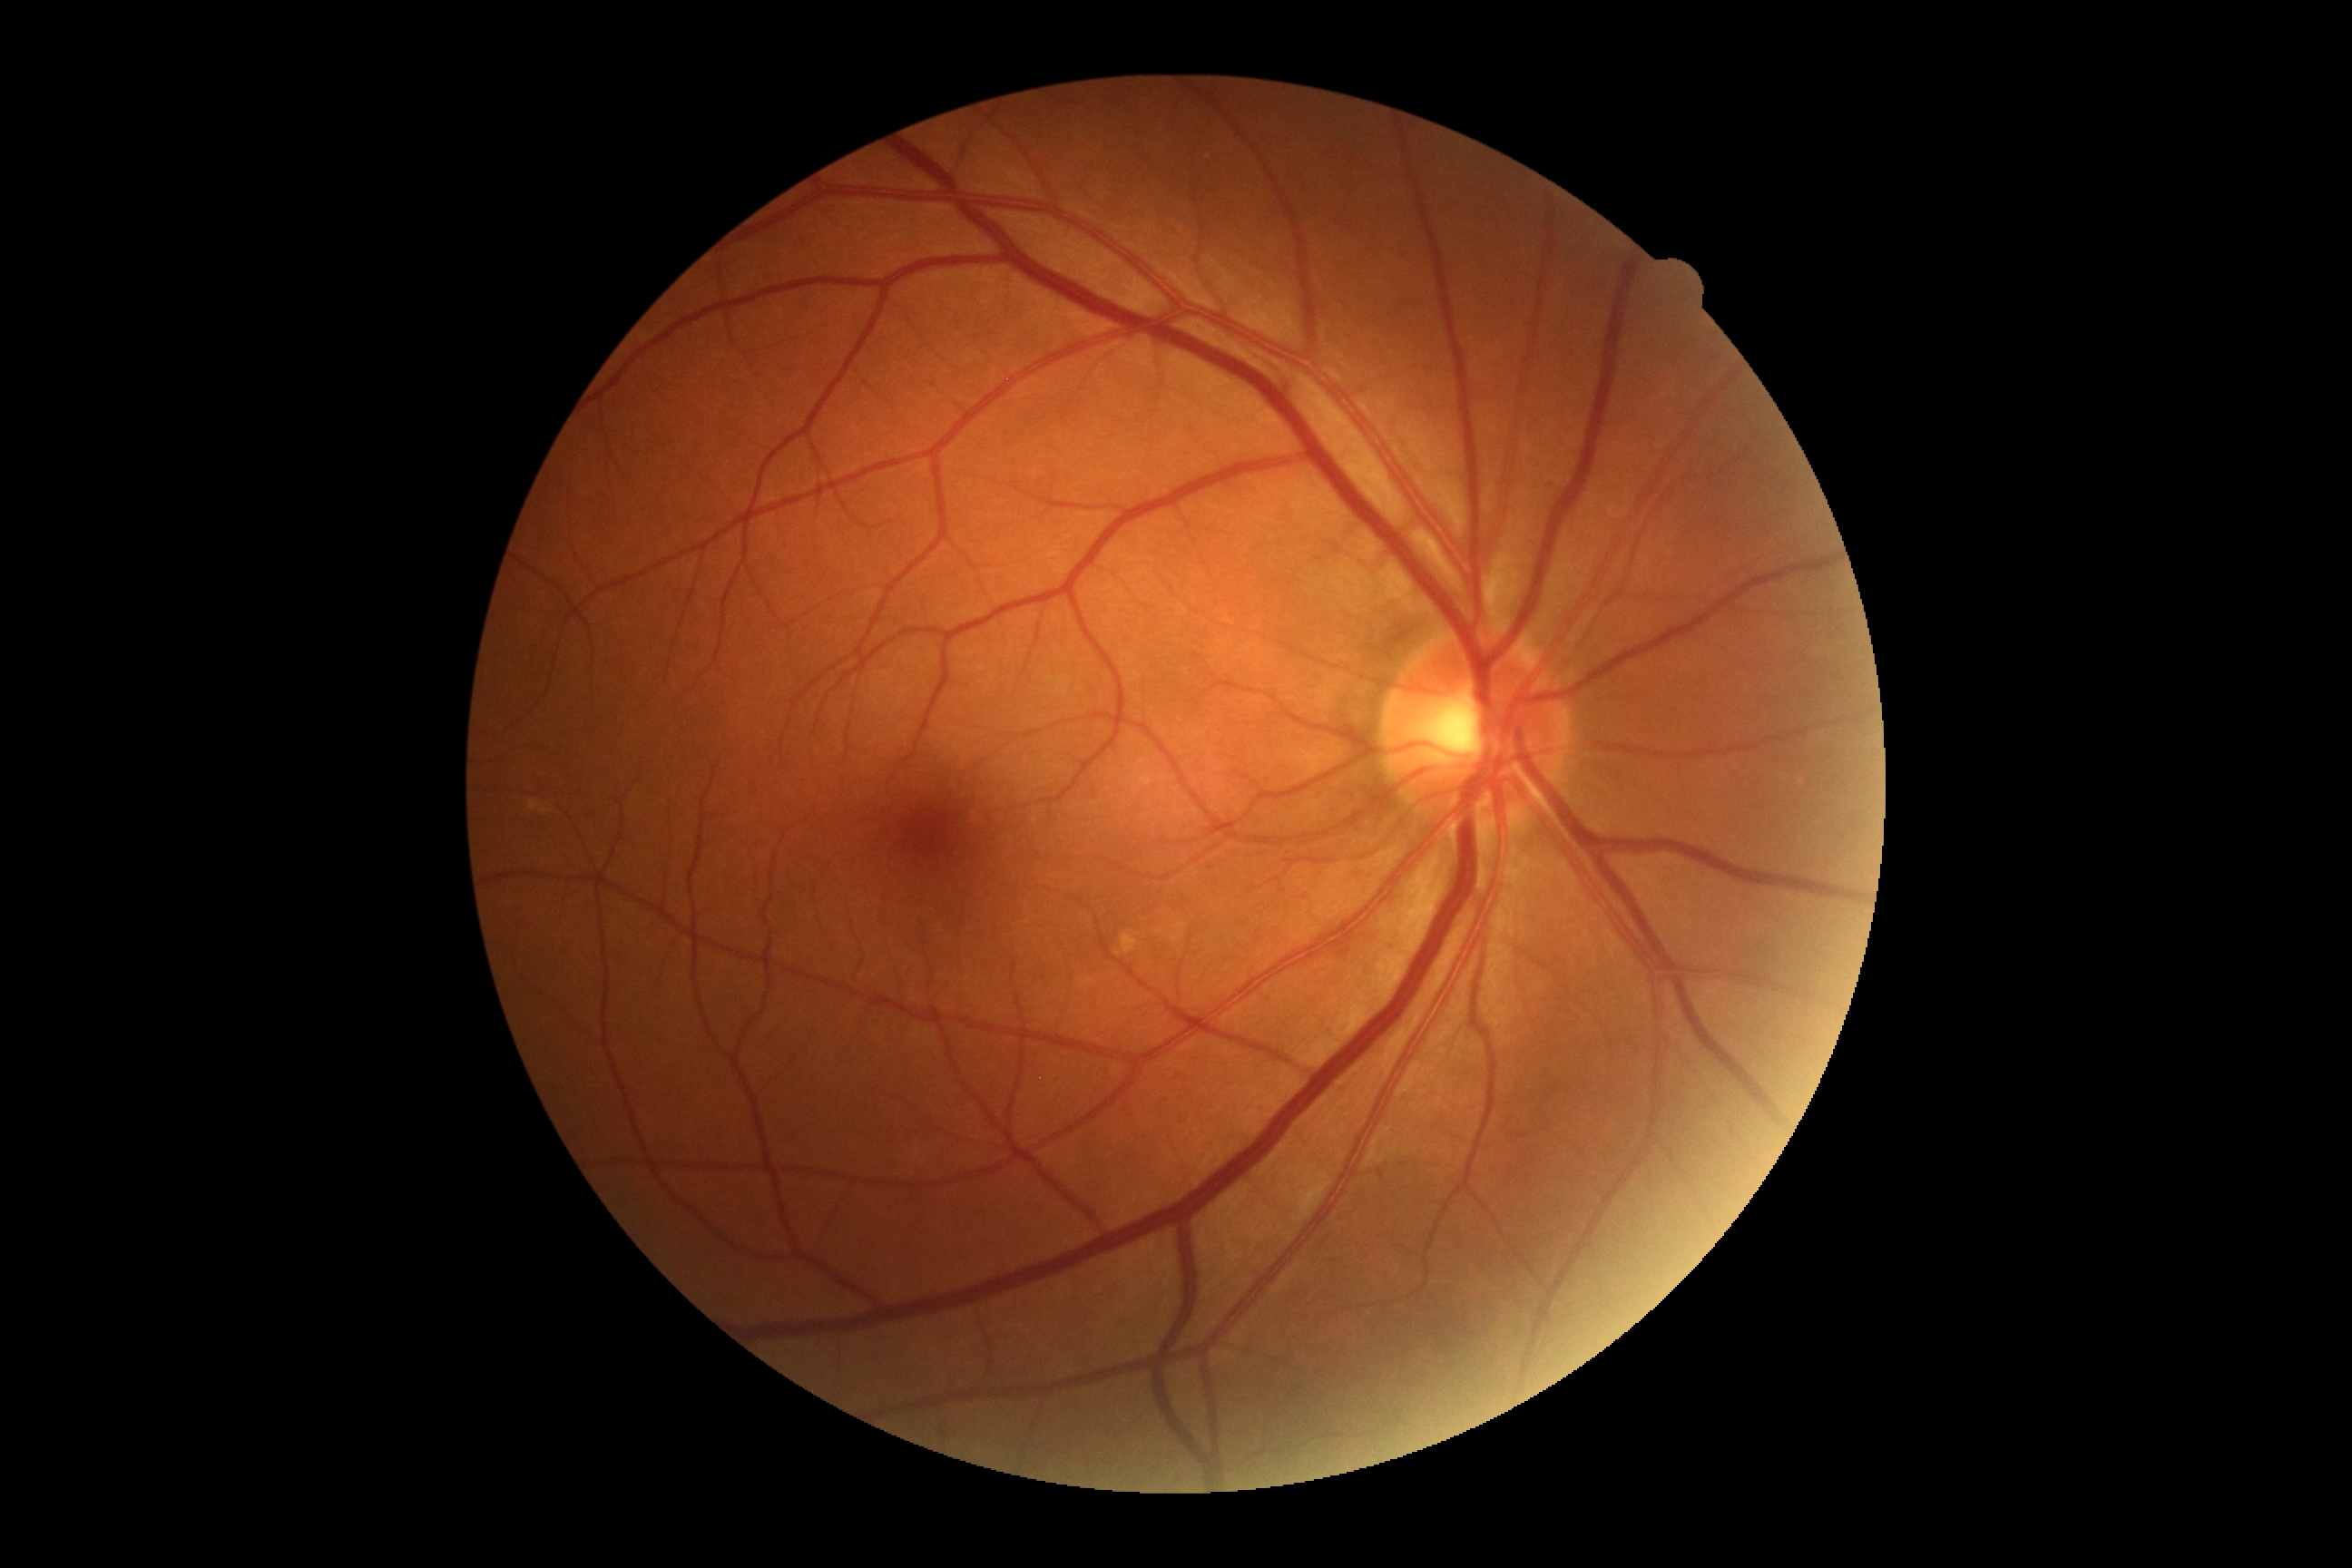 diabetic retinopathy severity=grade 0 — no visible signs of diabetic retinopathy; DR impression=negative for DR.